Acquired with a NIDEK AFC-230 · without pupil dilation
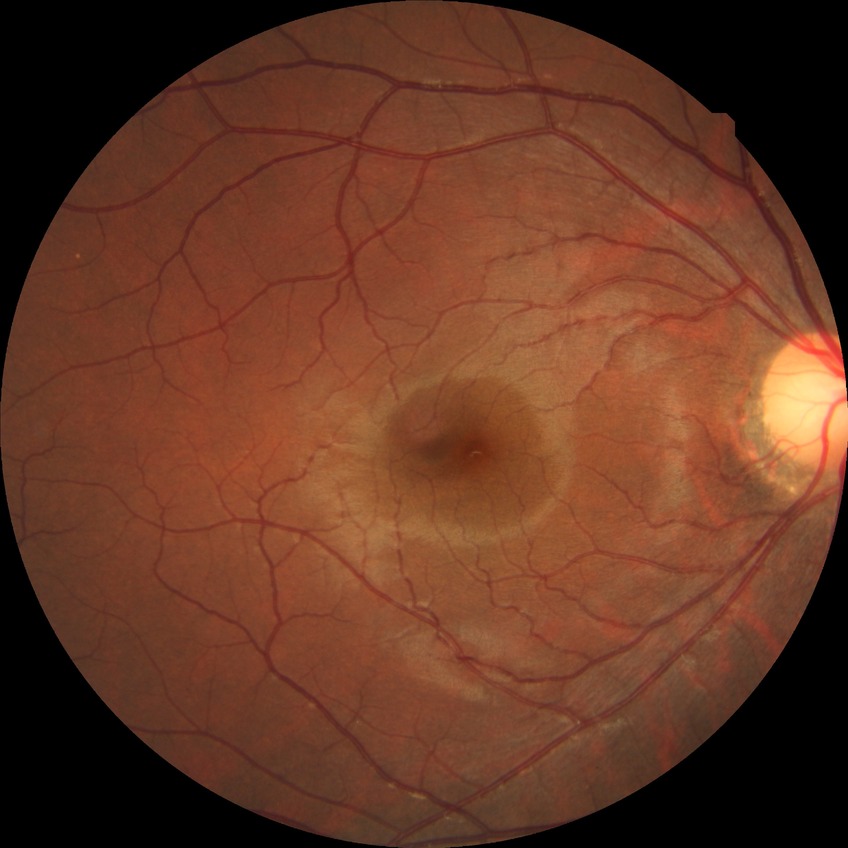
diabetic retinopathy (DR)=NDR (no diabetic retinopathy).